45° field of view — 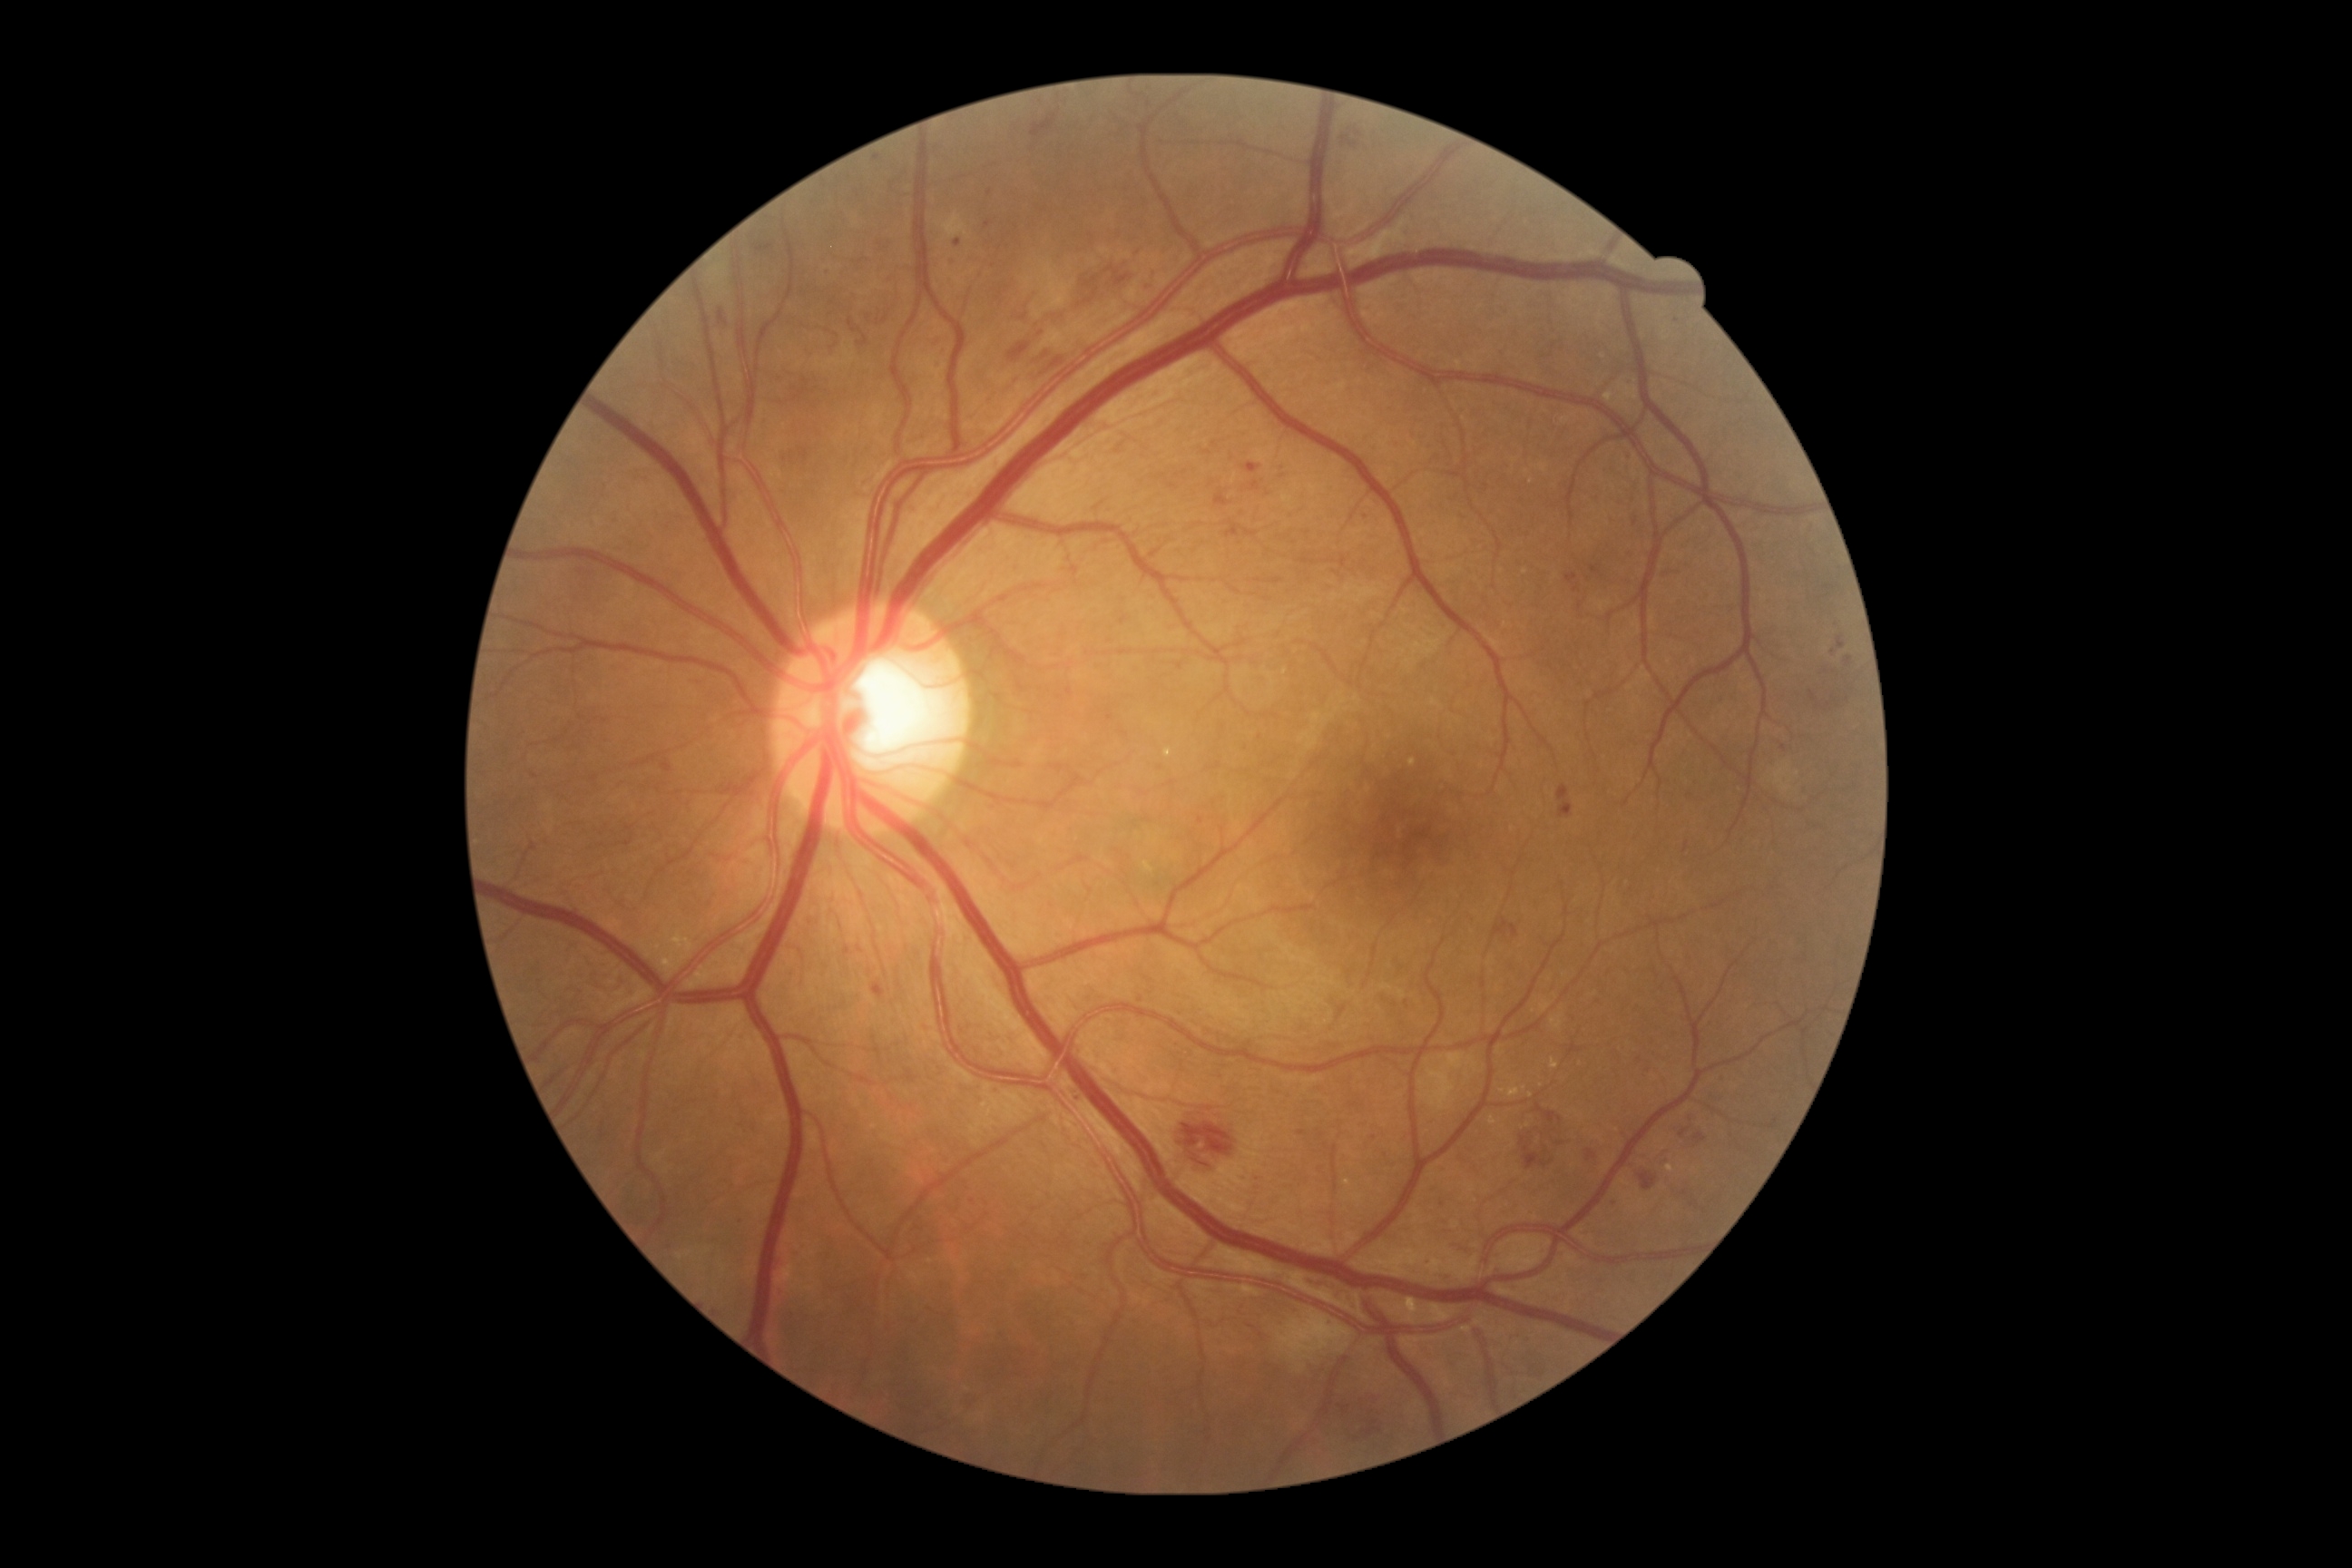

<lesions partial="true">
  <dr_grade>3</dr_grade>
  <ma partial="true">bbox(858, 946, 863, 954) | bbox(1845, 658, 1854, 667) | bbox(1250, 482, 1260, 491) | bbox(954, 239, 961, 248) | bbox(1611, 1195, 1618, 1204) | bbox(1244, 529, 1259, 538) | bbox(1244, 464, 1262, 475) | bbox(985, 220, 992, 228) | bbox(872, 981, 887, 999)</ma>
  <ma_small_centers>991, 192 | 1784, 748 | 1833, 653 | 1161, 768</ma_small_centers>
  <he partial="true">bbox(1810, 691, 1818, 701) | bbox(1524, 1106, 1567, 1171) | bbox(1304, 1280, 1362, 1311) | bbox(1638, 1171, 1658, 1191) | bbox(1340, 121, 1364, 148) | bbox(756, 244, 774, 253) | bbox(1070, 262, 1141, 315) | bbox(720, 309, 729, 326) | bbox(1032, 115, 1057, 137)</he>
  <he_small_centers>1828, 706 | 1848, 700</he_small_centers>
</lesions>